45-degree field of view — 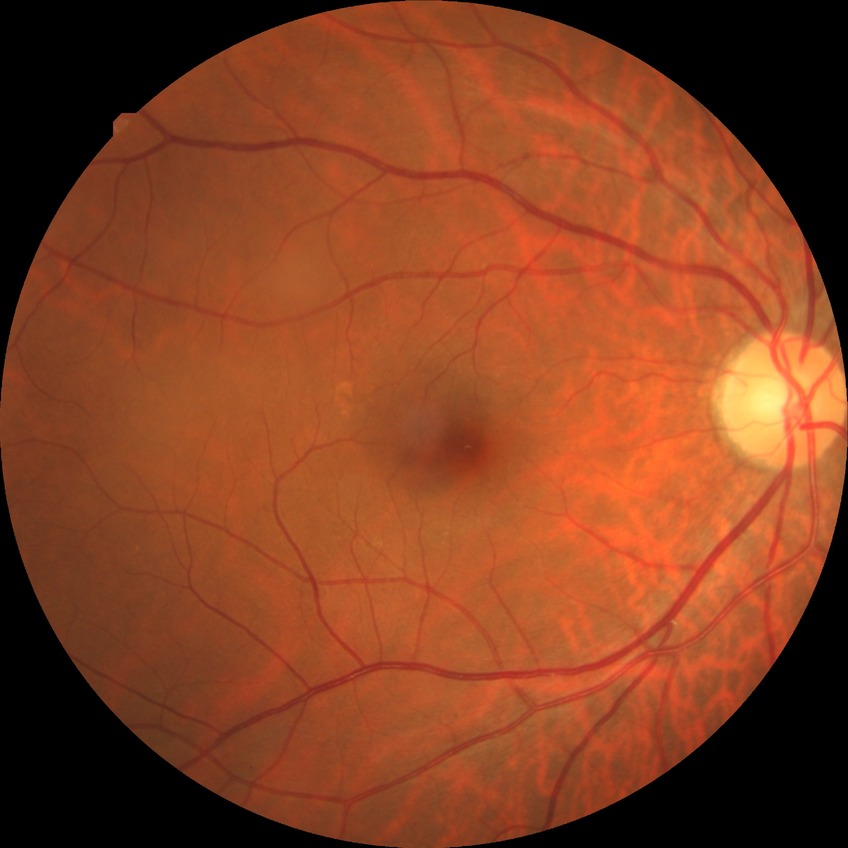 Assessment:
– modified Davis grade: NDR